CFP
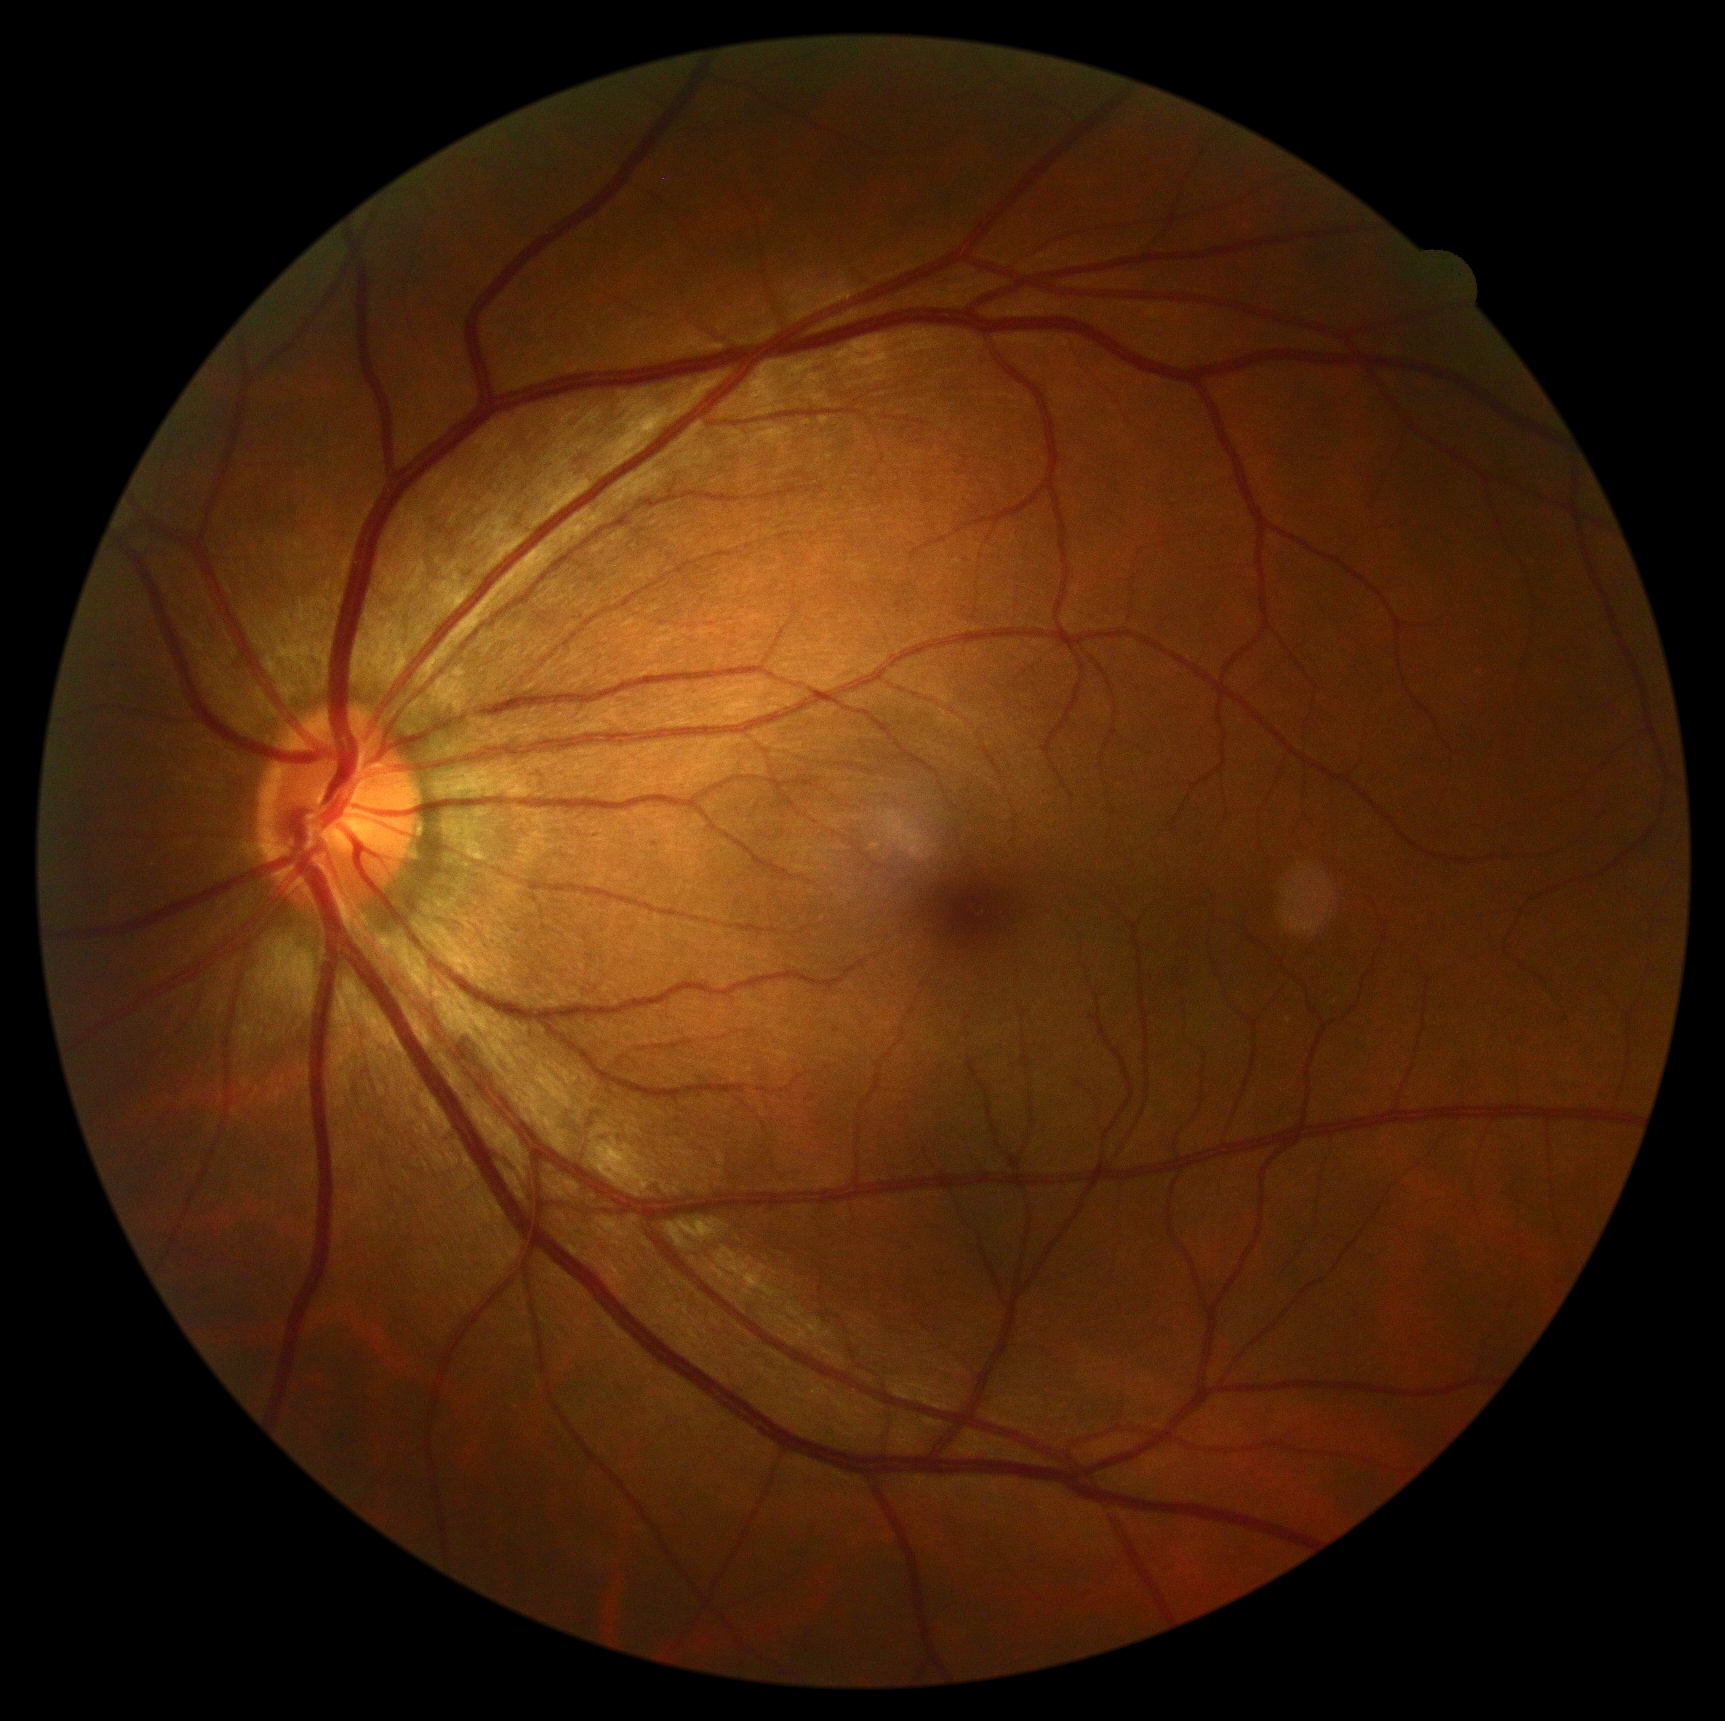 DR severity: 0.